Color fundus photograph. FOV: 45 degrees: 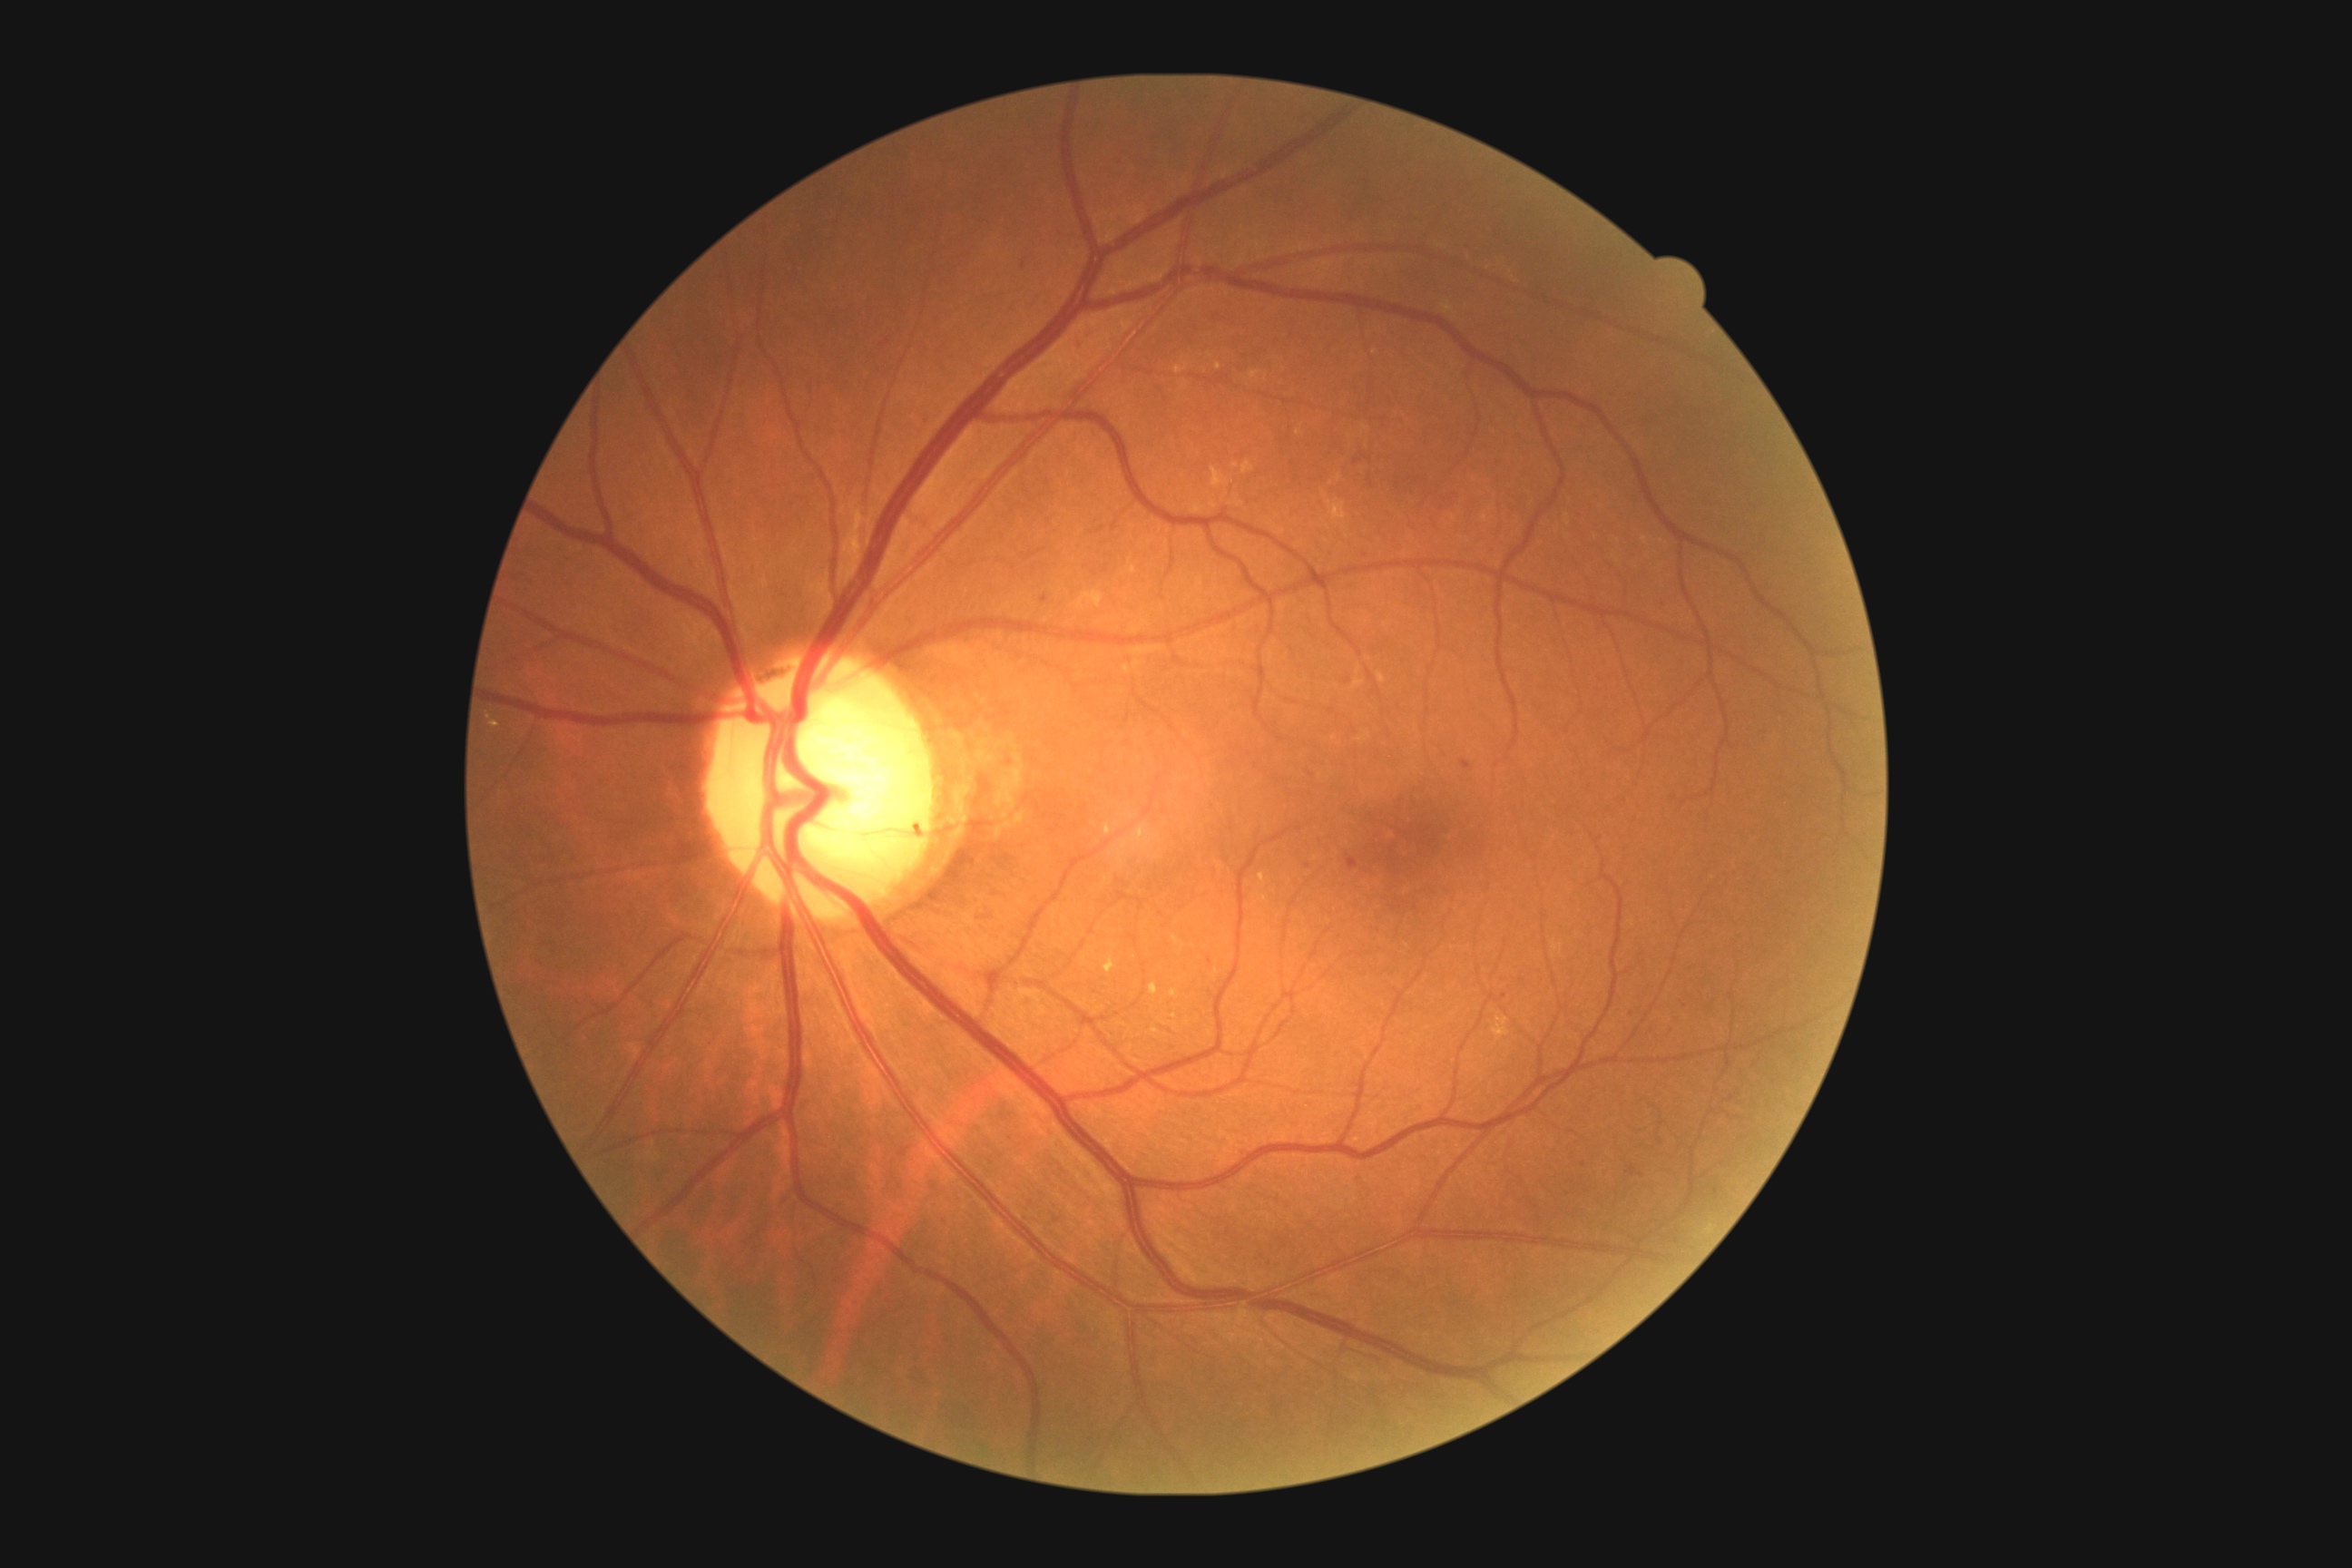
DR stage is 2/4.